130° field of view (Clarity RetCam 3) · pediatric wide-field fundus photograph · 640x480.
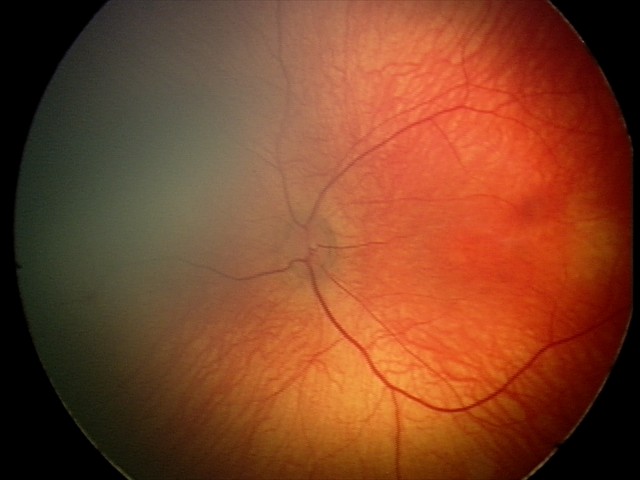

Normal screening examination.